Davis DR grading; 848 by 848 pixels.
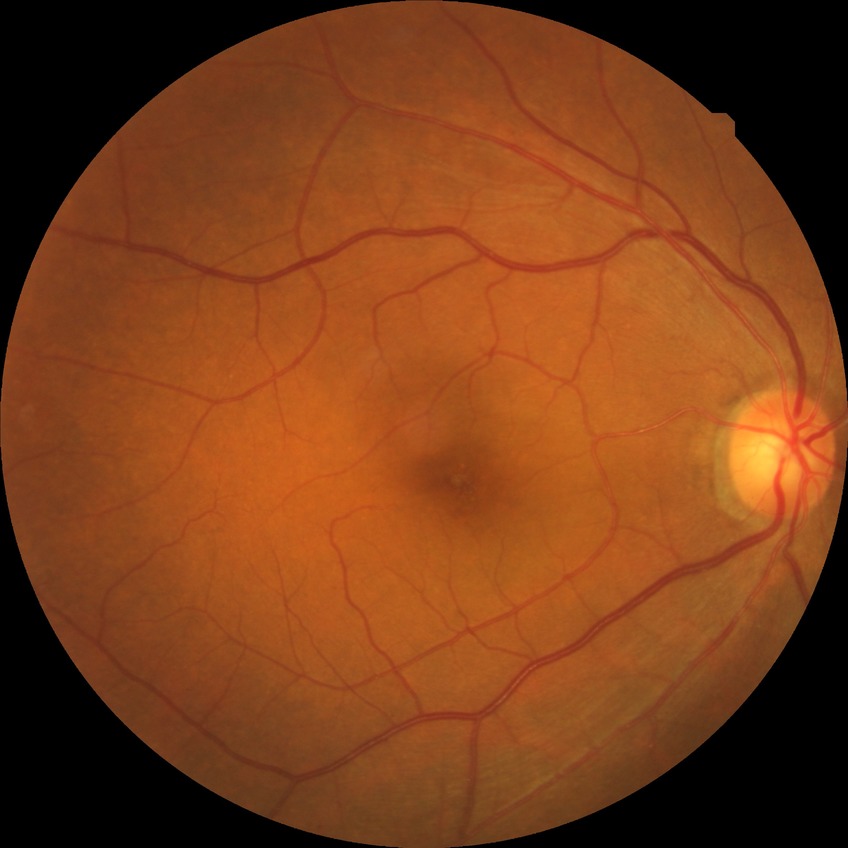 Davis grading is no diabetic retinopathy.